Retinal fundus photograph. Image size 2212x1659. 45° field of view:
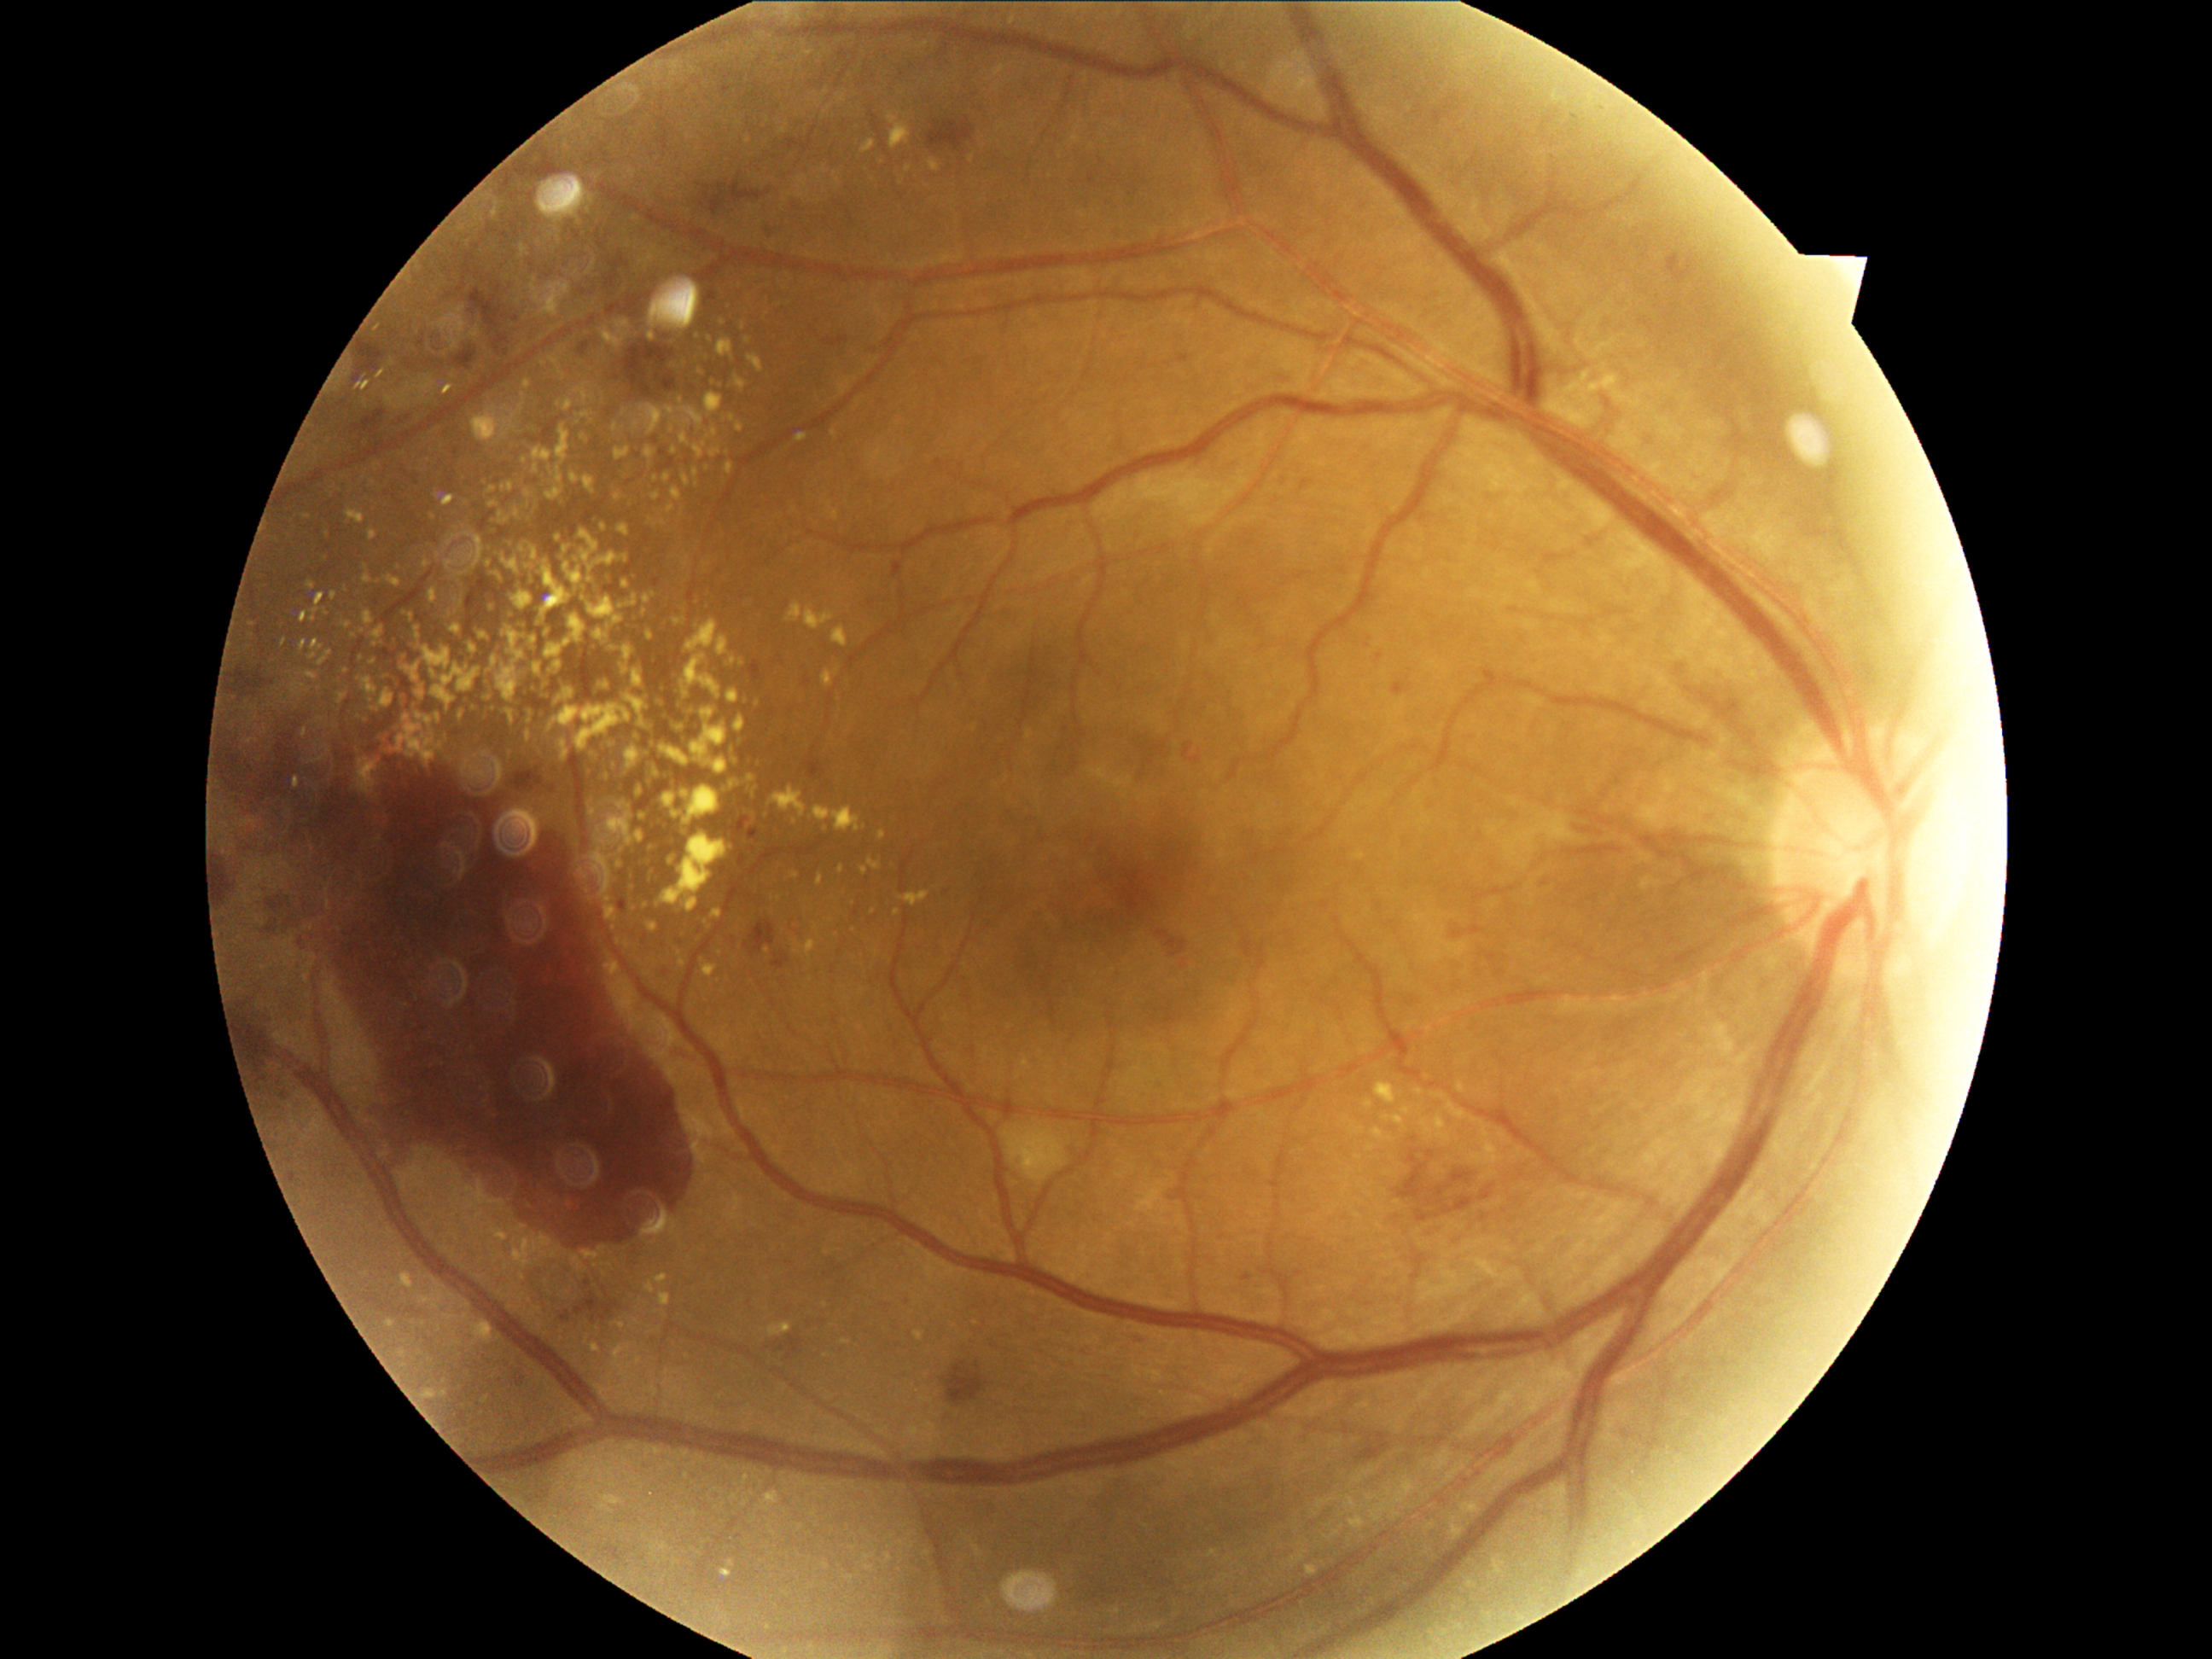
Retinopathy grade: 4 (PDR). Hard exudates are present, including at bbox(706, 393, 723, 416) | bbox(788, 605, 803, 620) | bbox(498, 667, 518, 702) | bbox(431, 670, 438, 678) | bbox(443, 496, 457, 506) | bbox(1394, 1115, 1404, 1124) | bbox(634, 667, 643, 687) | bbox(441, 1390, 446, 1399) | bbox(458, 569, 469, 576) | bbox(690, 598, 699, 605) | bbox(1453, 1527, 1464, 1537). Smaller hard exudates around (873, 912) | (486, 756) | (506, 521) | (462, 603) | (654, 662) | (875, 455) | (349, 624) | (1424, 1124).